45 degree fundus photograph: 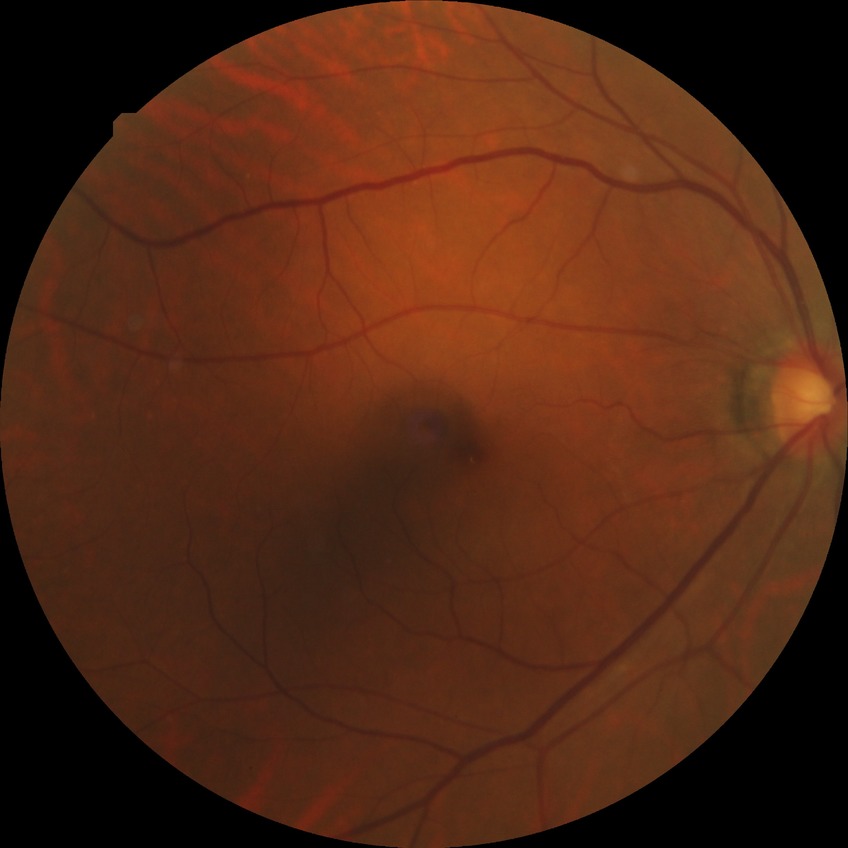

davis_grade: no diabetic retinopathy (NDR)